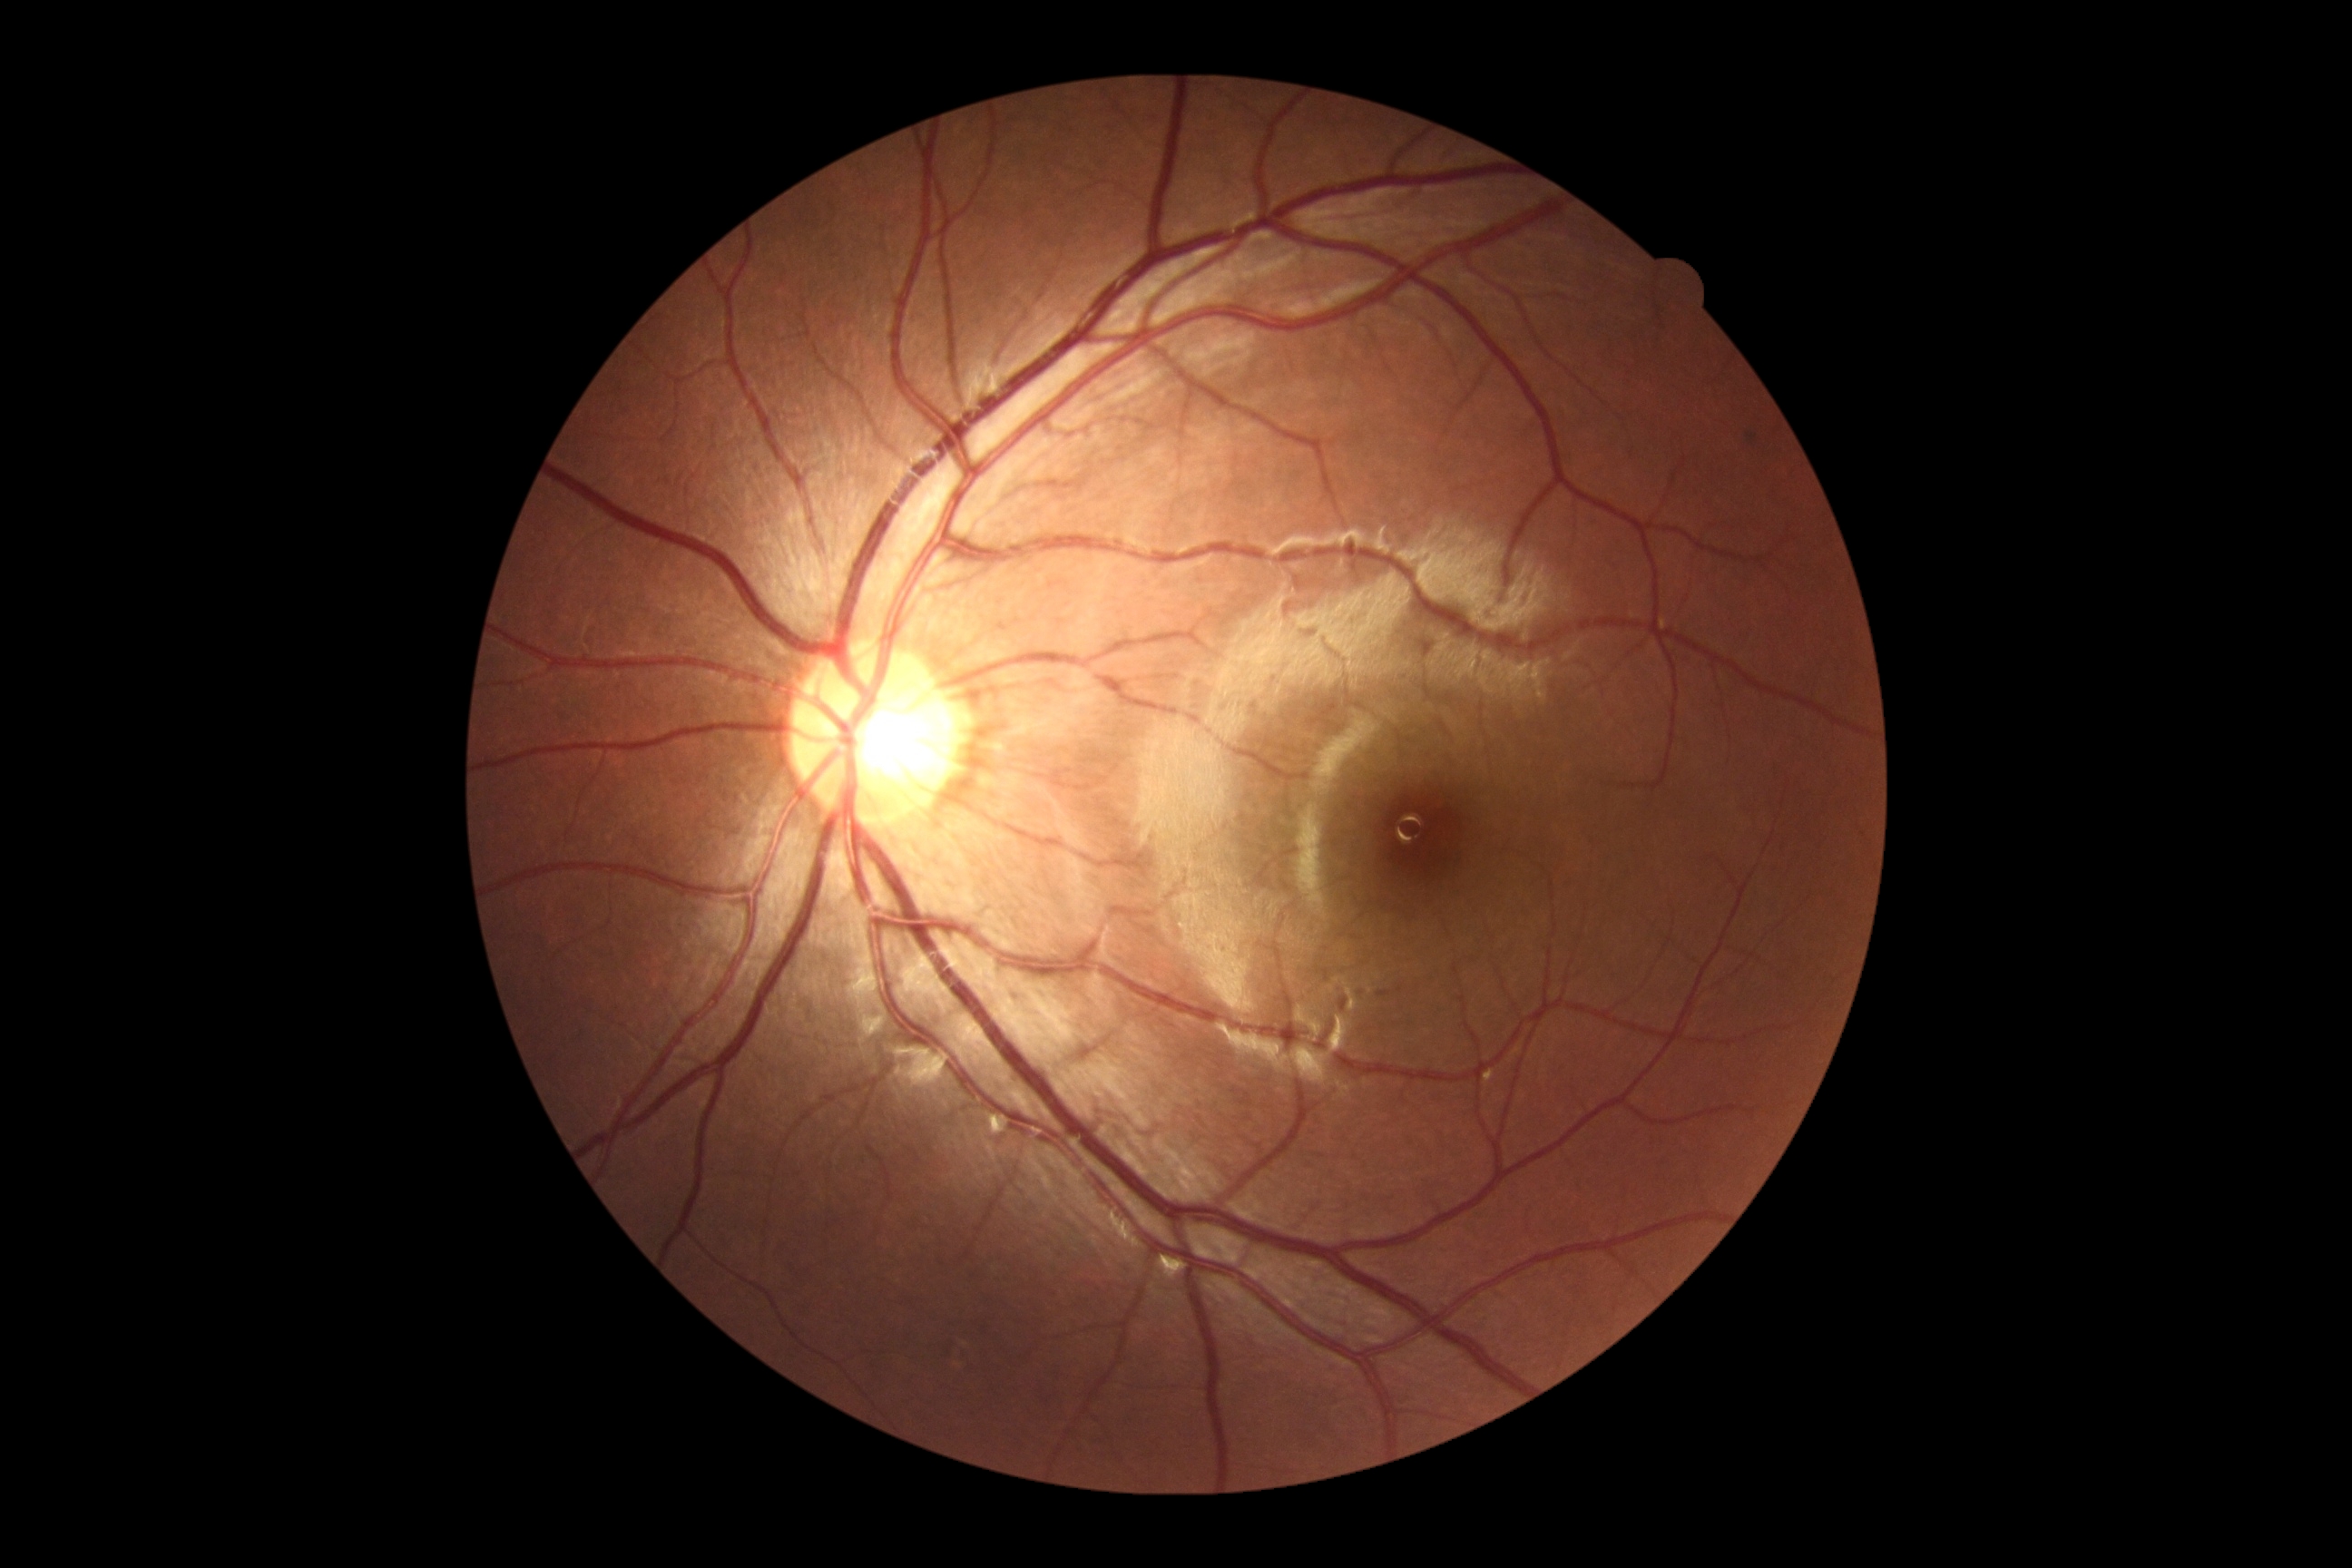

DR: 0/4.
No signs of diabetic retinopathy.